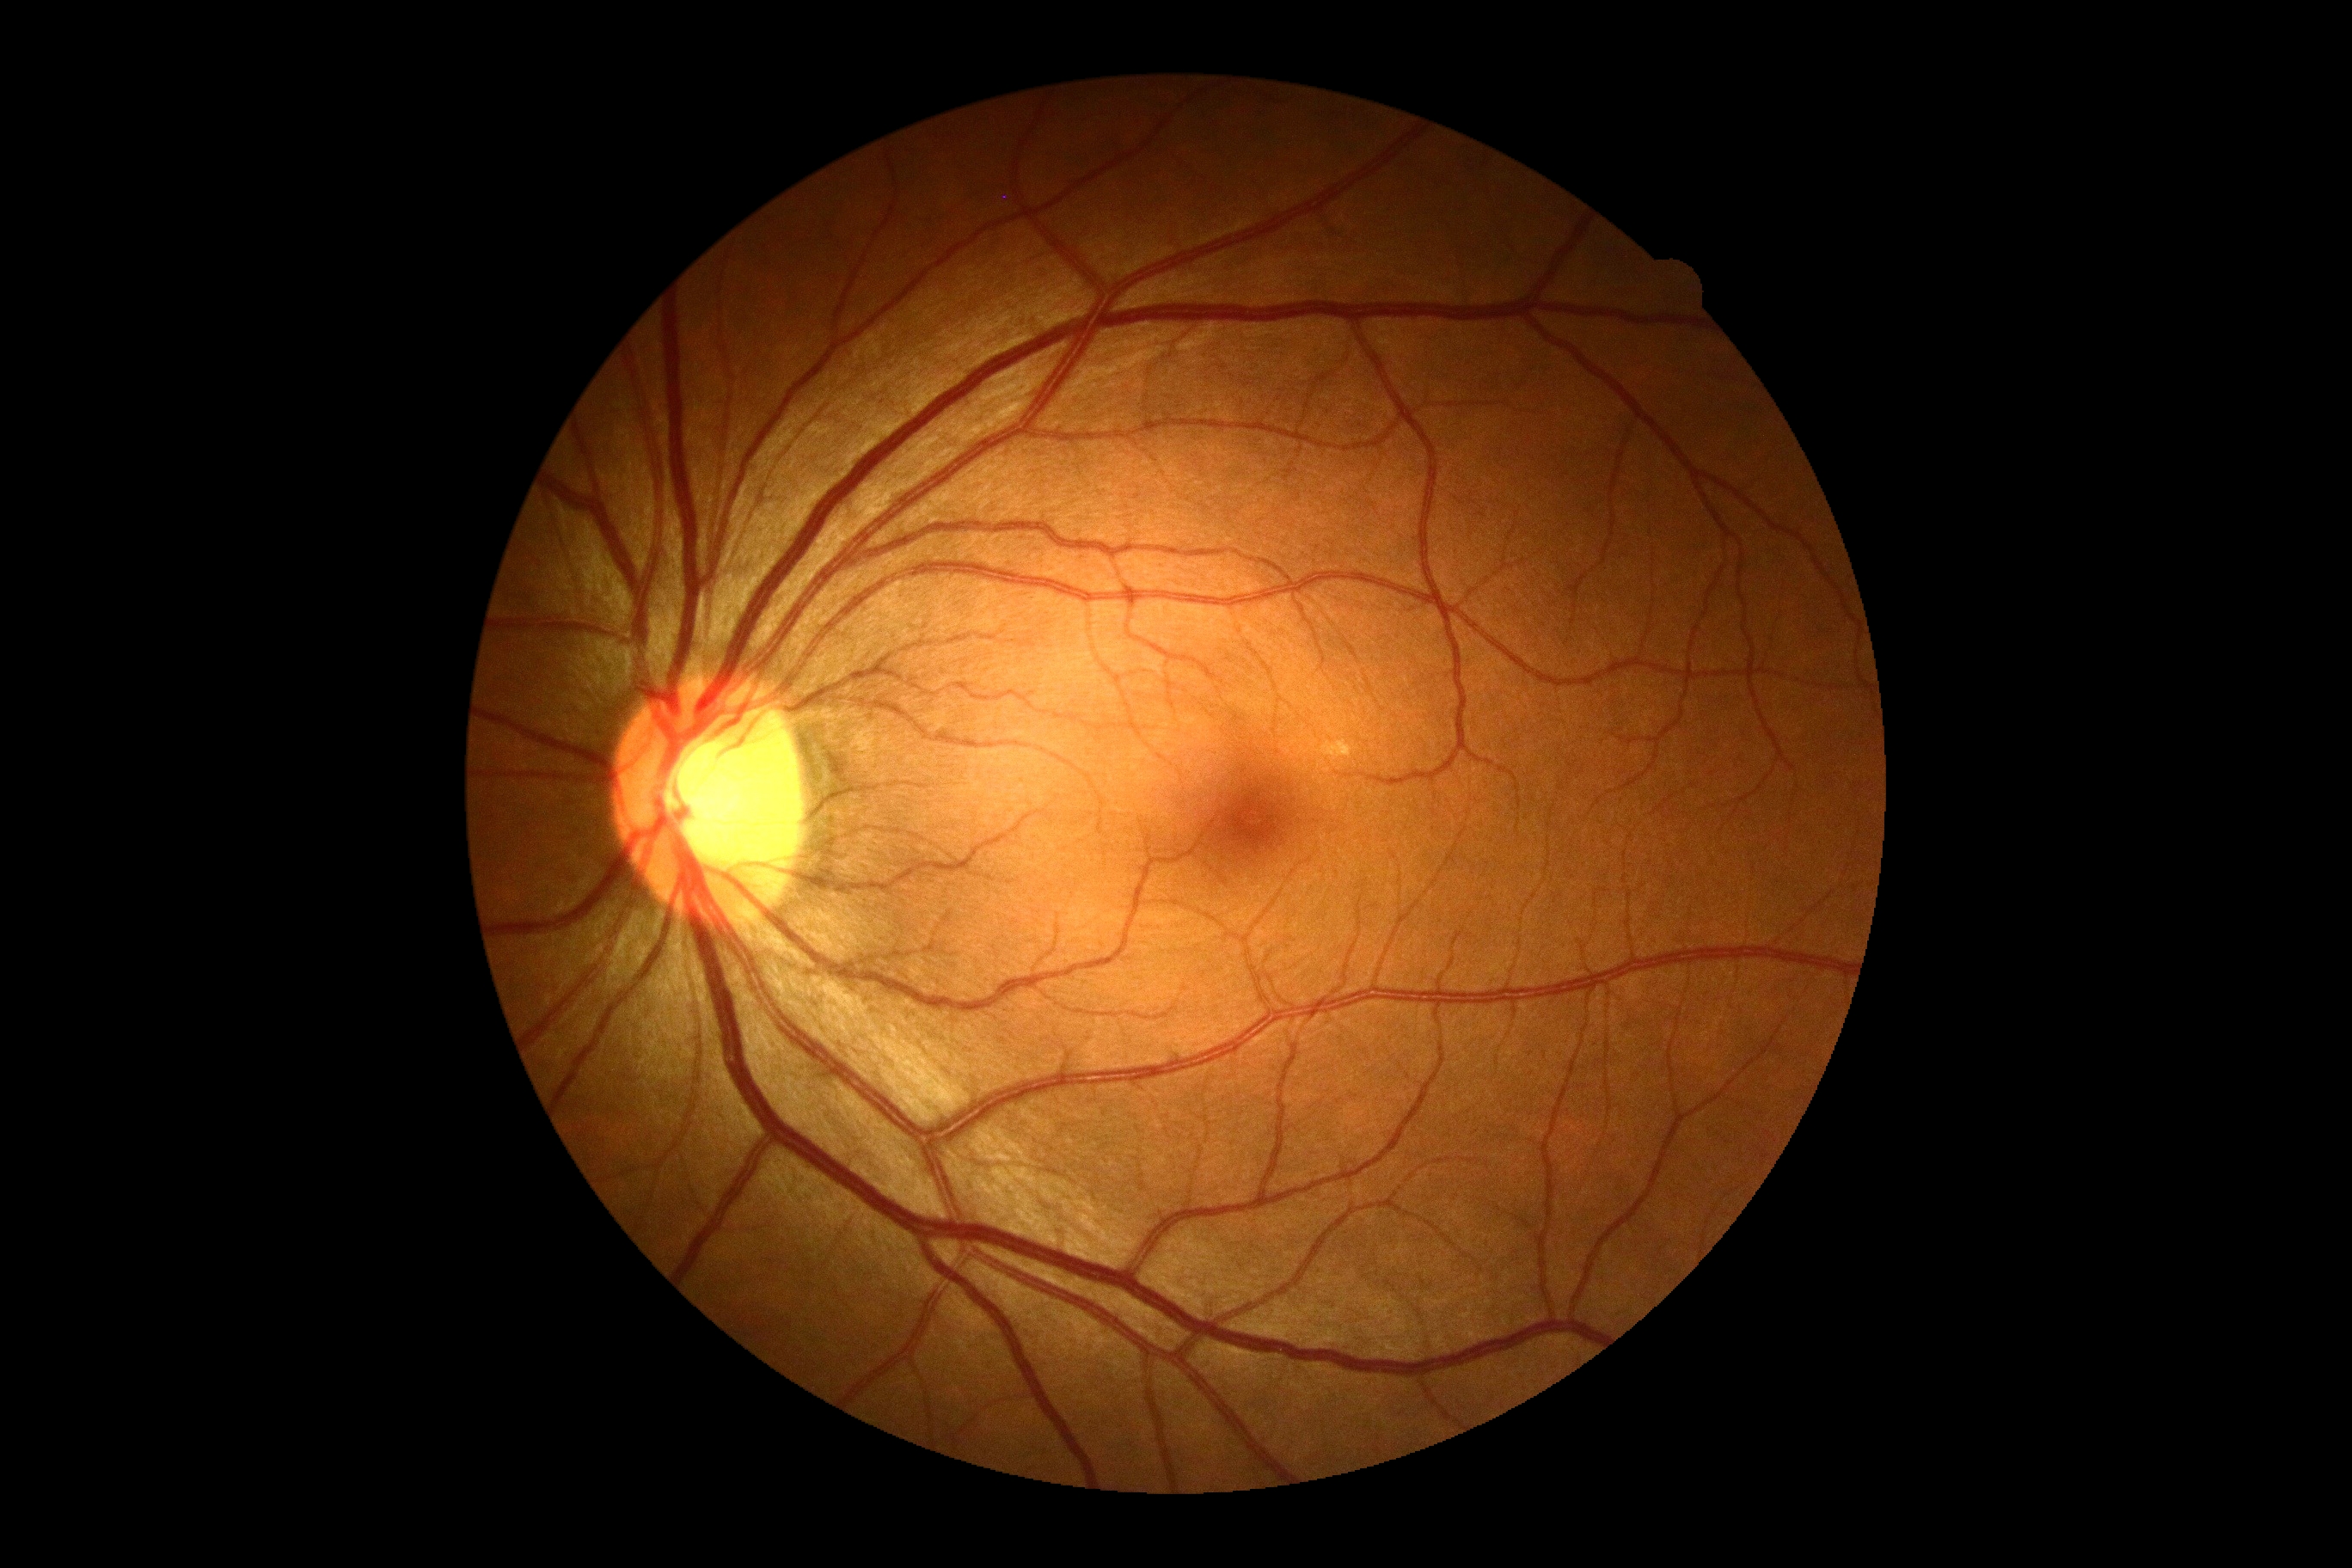

Retinopathy: 0.